Wide-field contact fundus photograph of an infant: 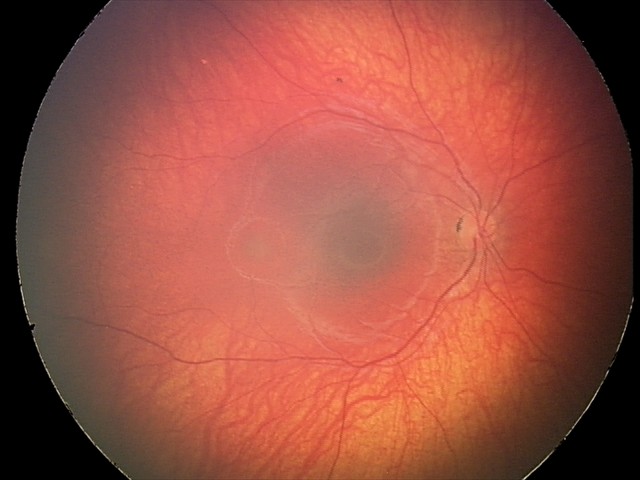
Screening examination consistent with retinal astrocytic hamartoma.